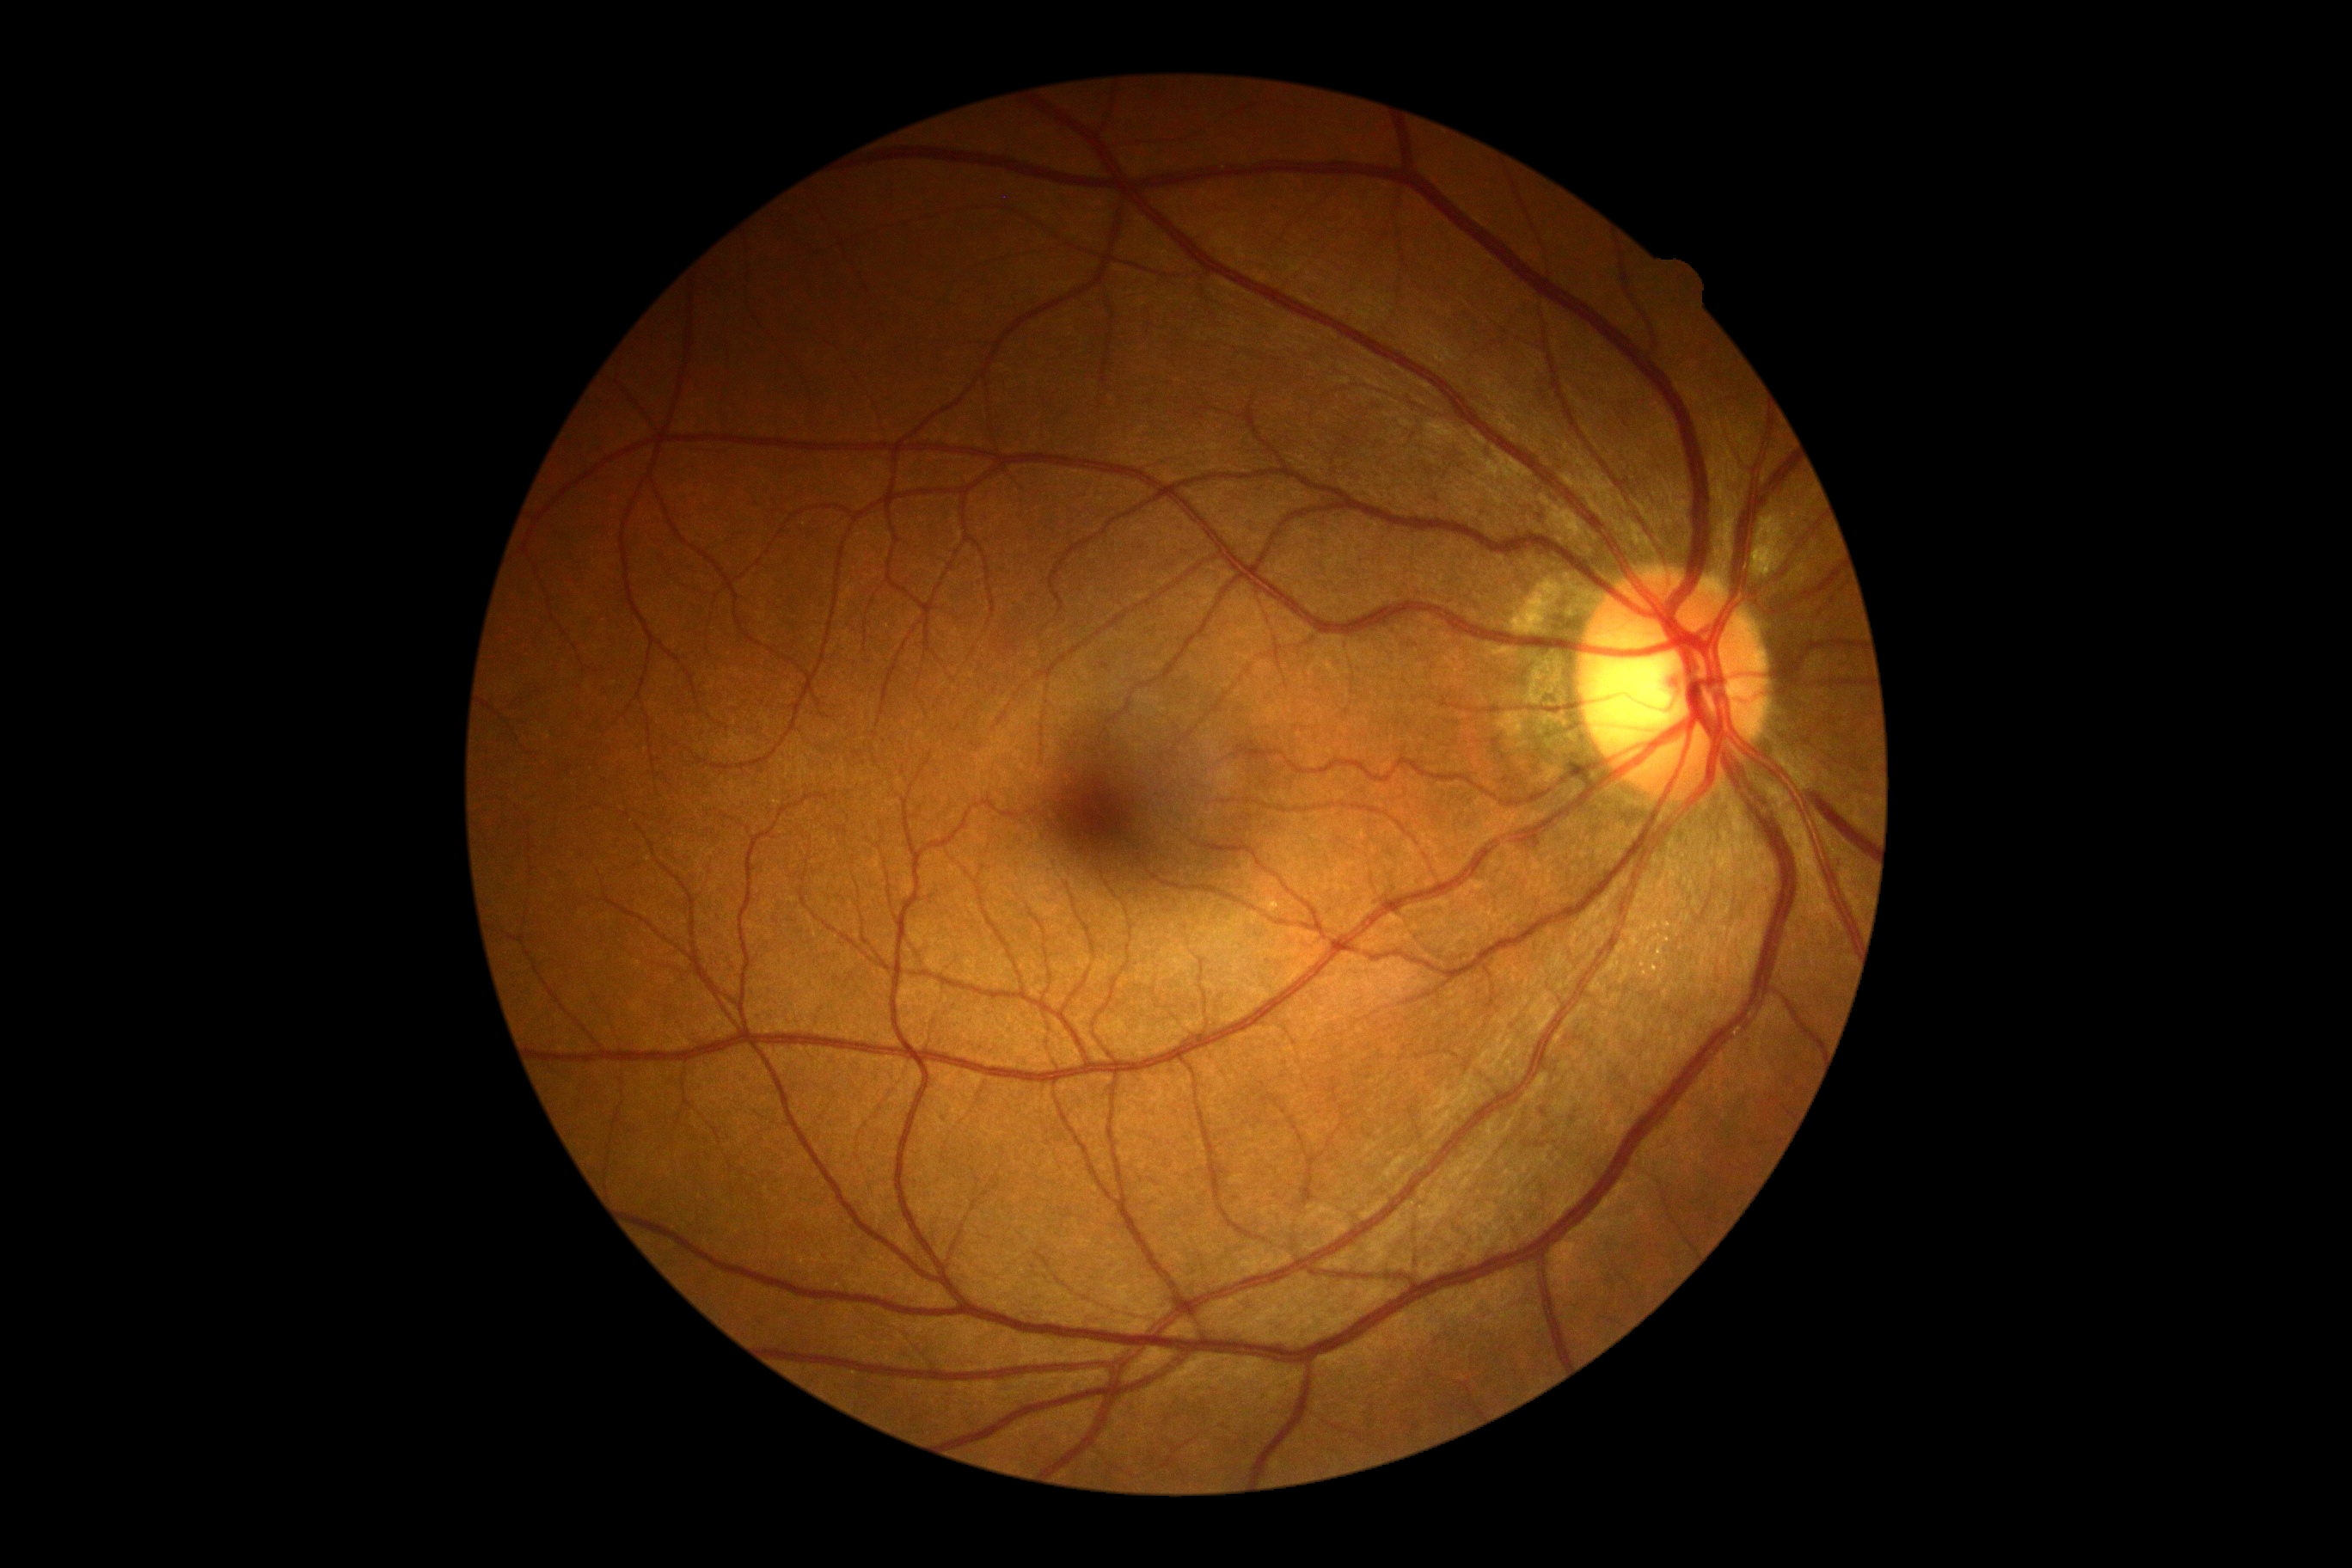 No apparent diabetic retinopathy. Diabetic retinopathy (DR): grade 0.